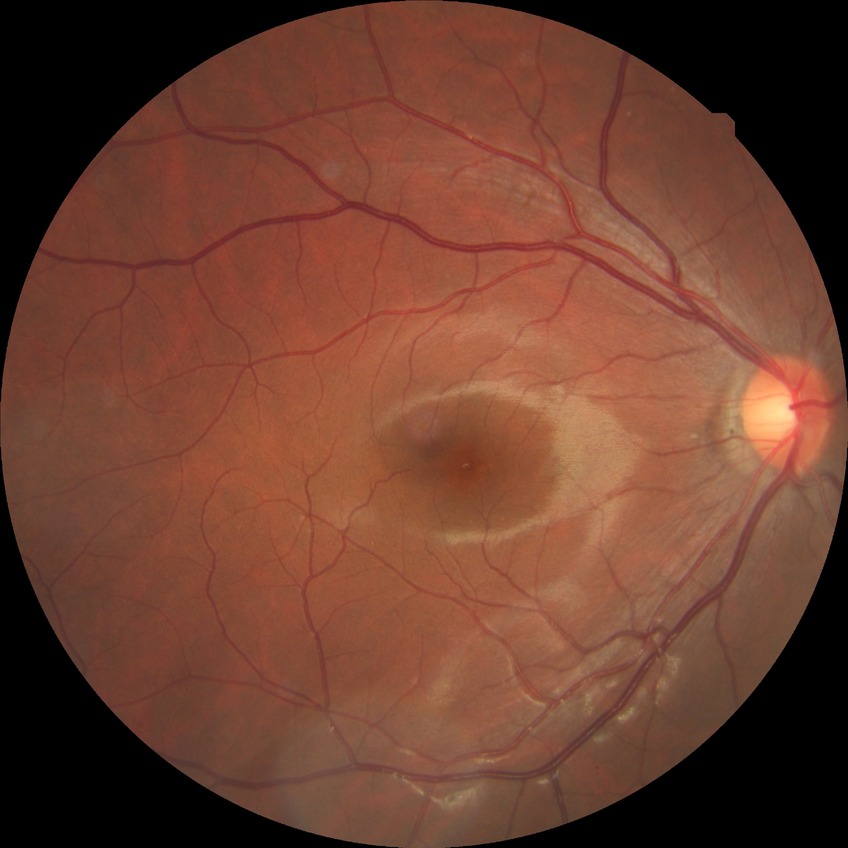

retinopathy stage: no diabetic retinopathy.